Infant wide-field retinal image · 640x480 · captured with the Clarity RetCam 3 (130° field of view):
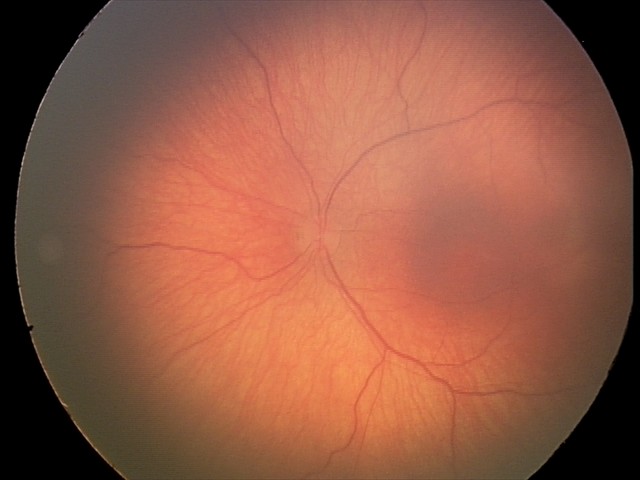

Impression: retinopathy of prematurity stage 1; no plus disease.